Graded on the modified Davis scale:
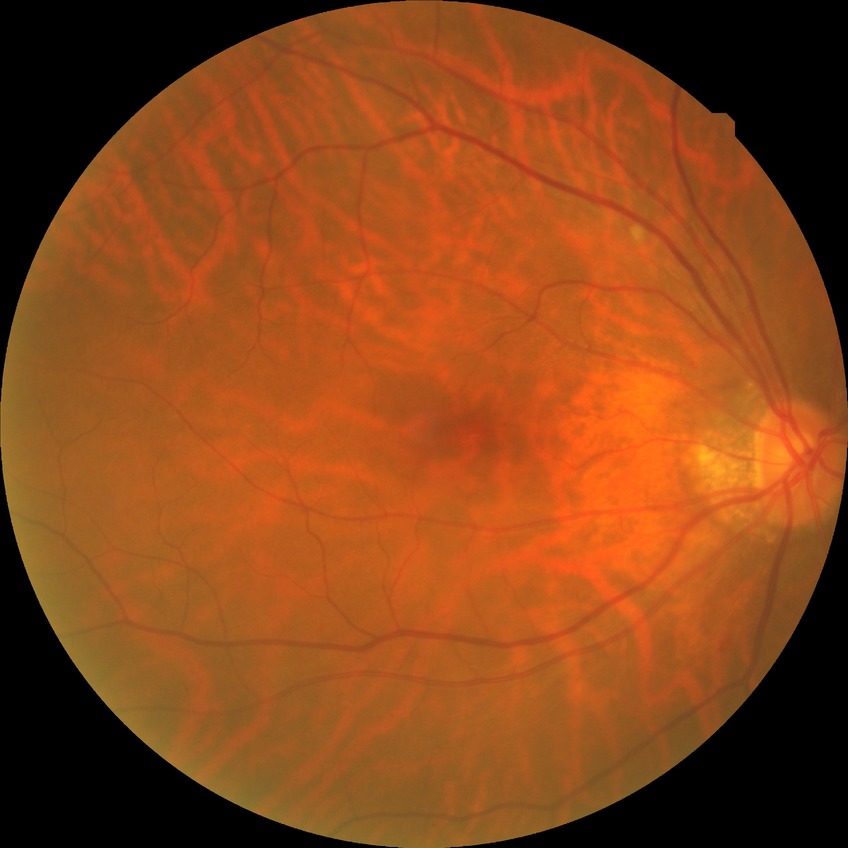 {"davis_grade": "NDR (no diabetic retinopathy)"}